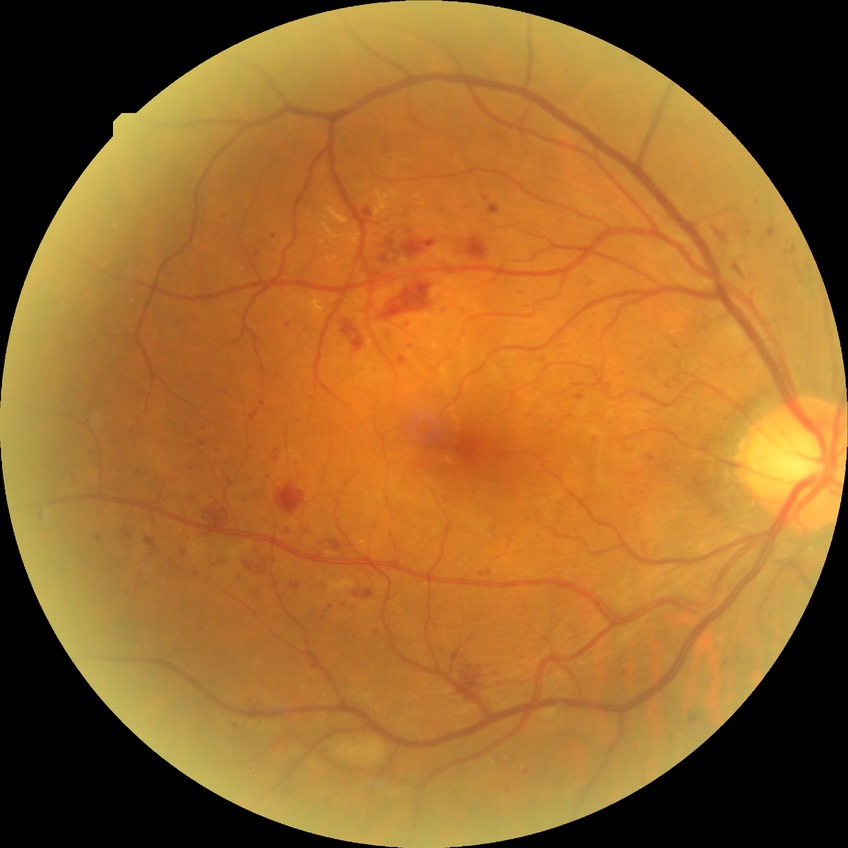

Diabetic retinopathy (DR): PPDR (pre-proliferative diabetic retinopathy).